50° FOV — 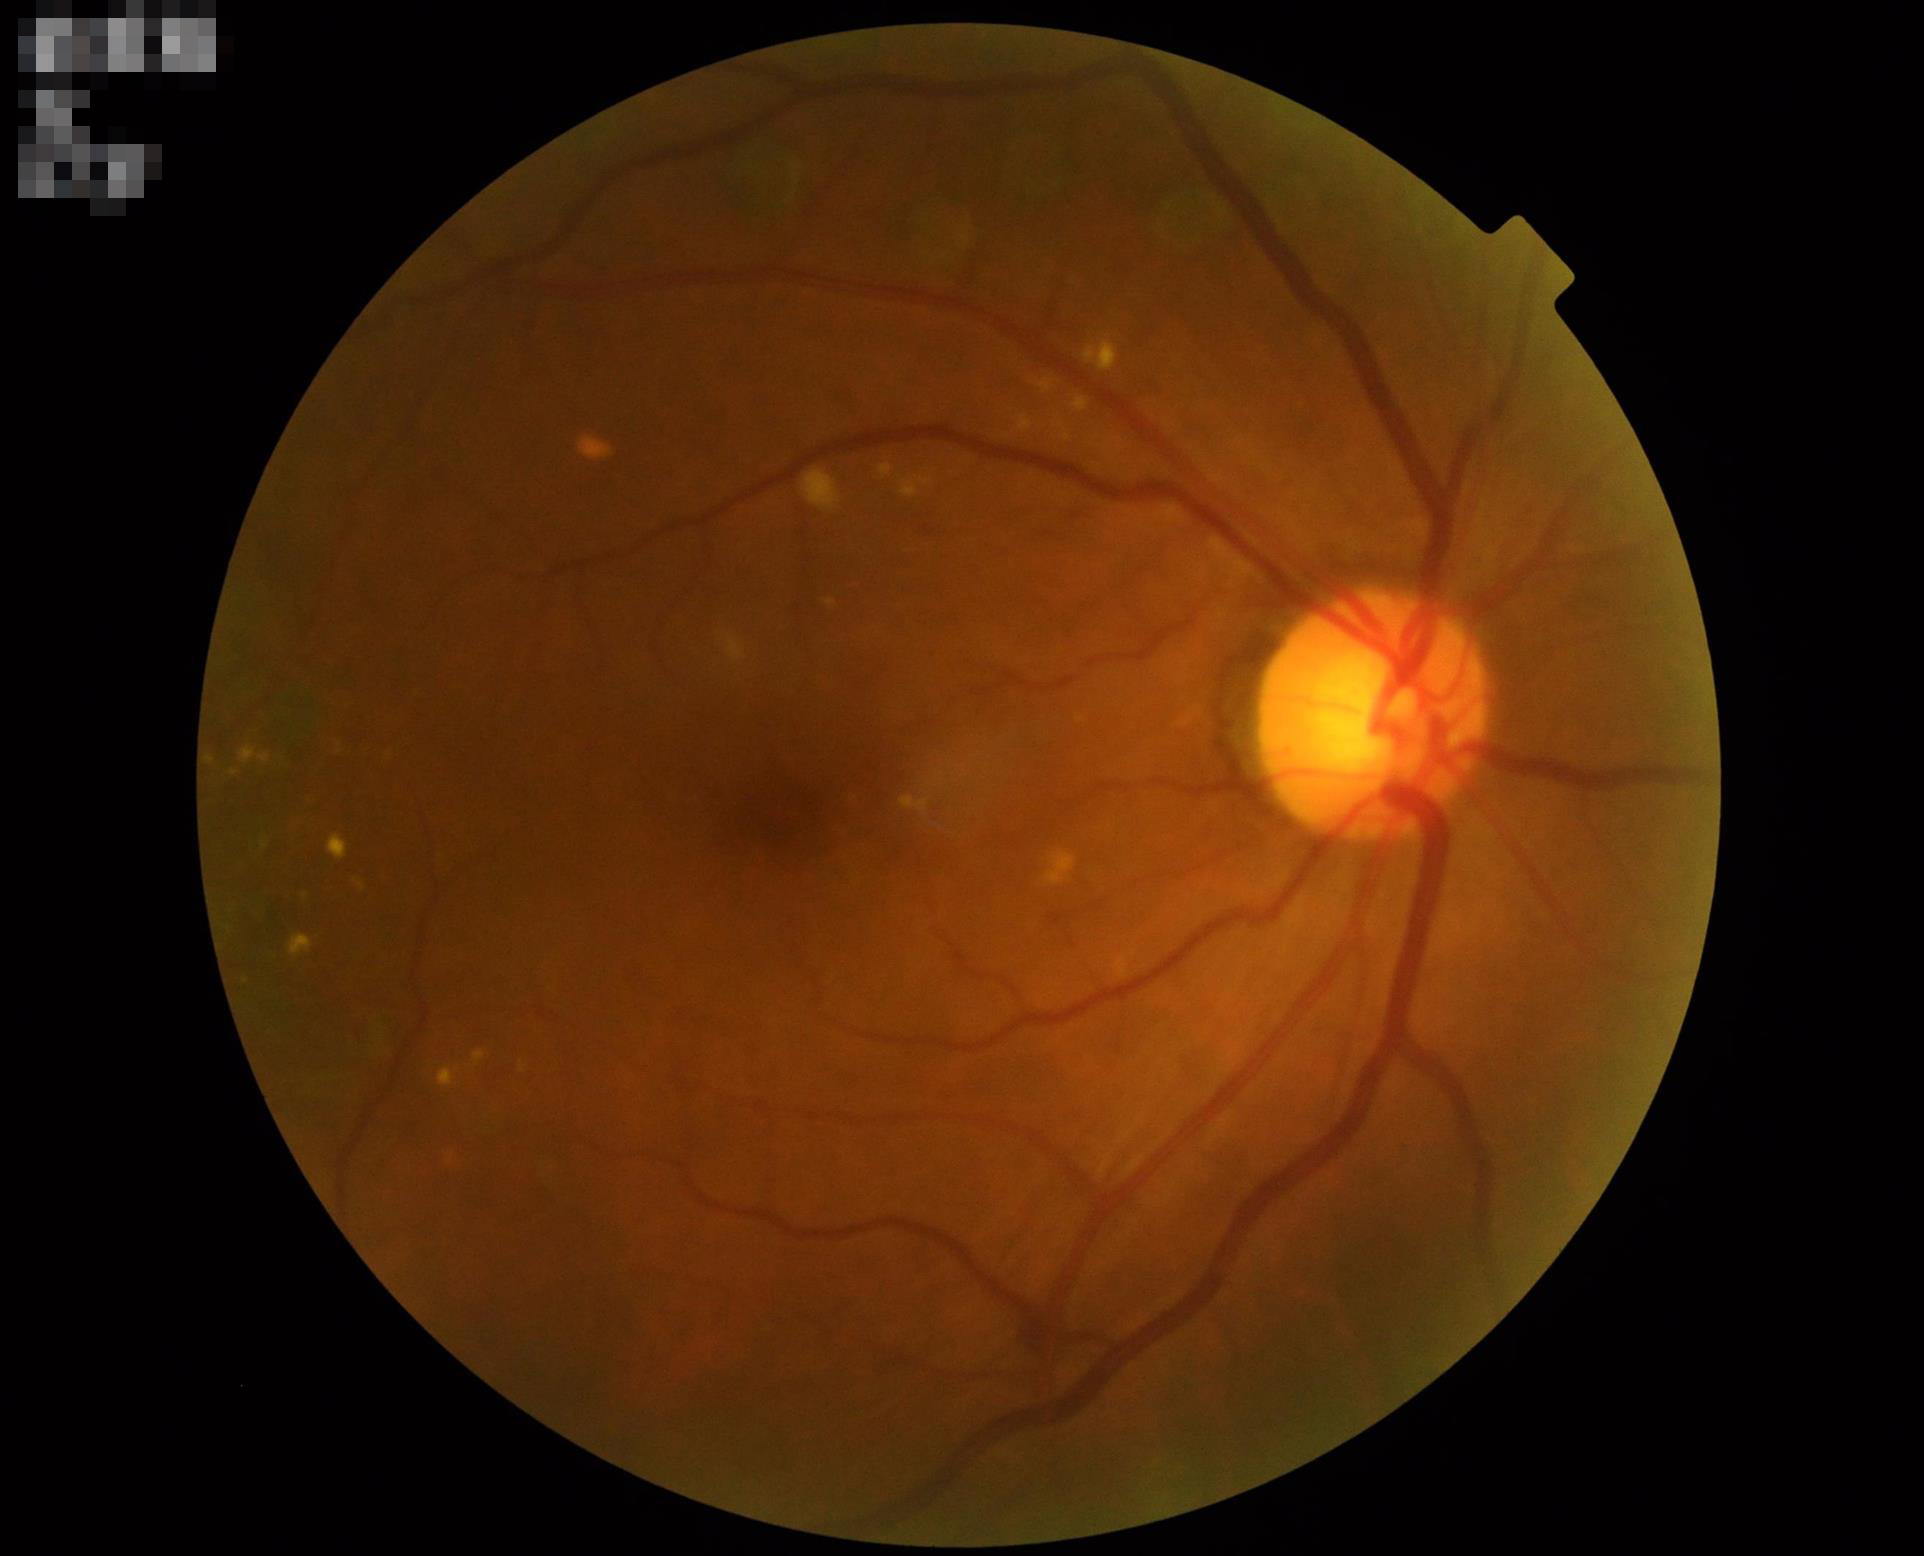
Sharpness = optic disc, vessels, and background in focus; Overall = good and suitable for diagnostic use; Contrast = good dynamic range.